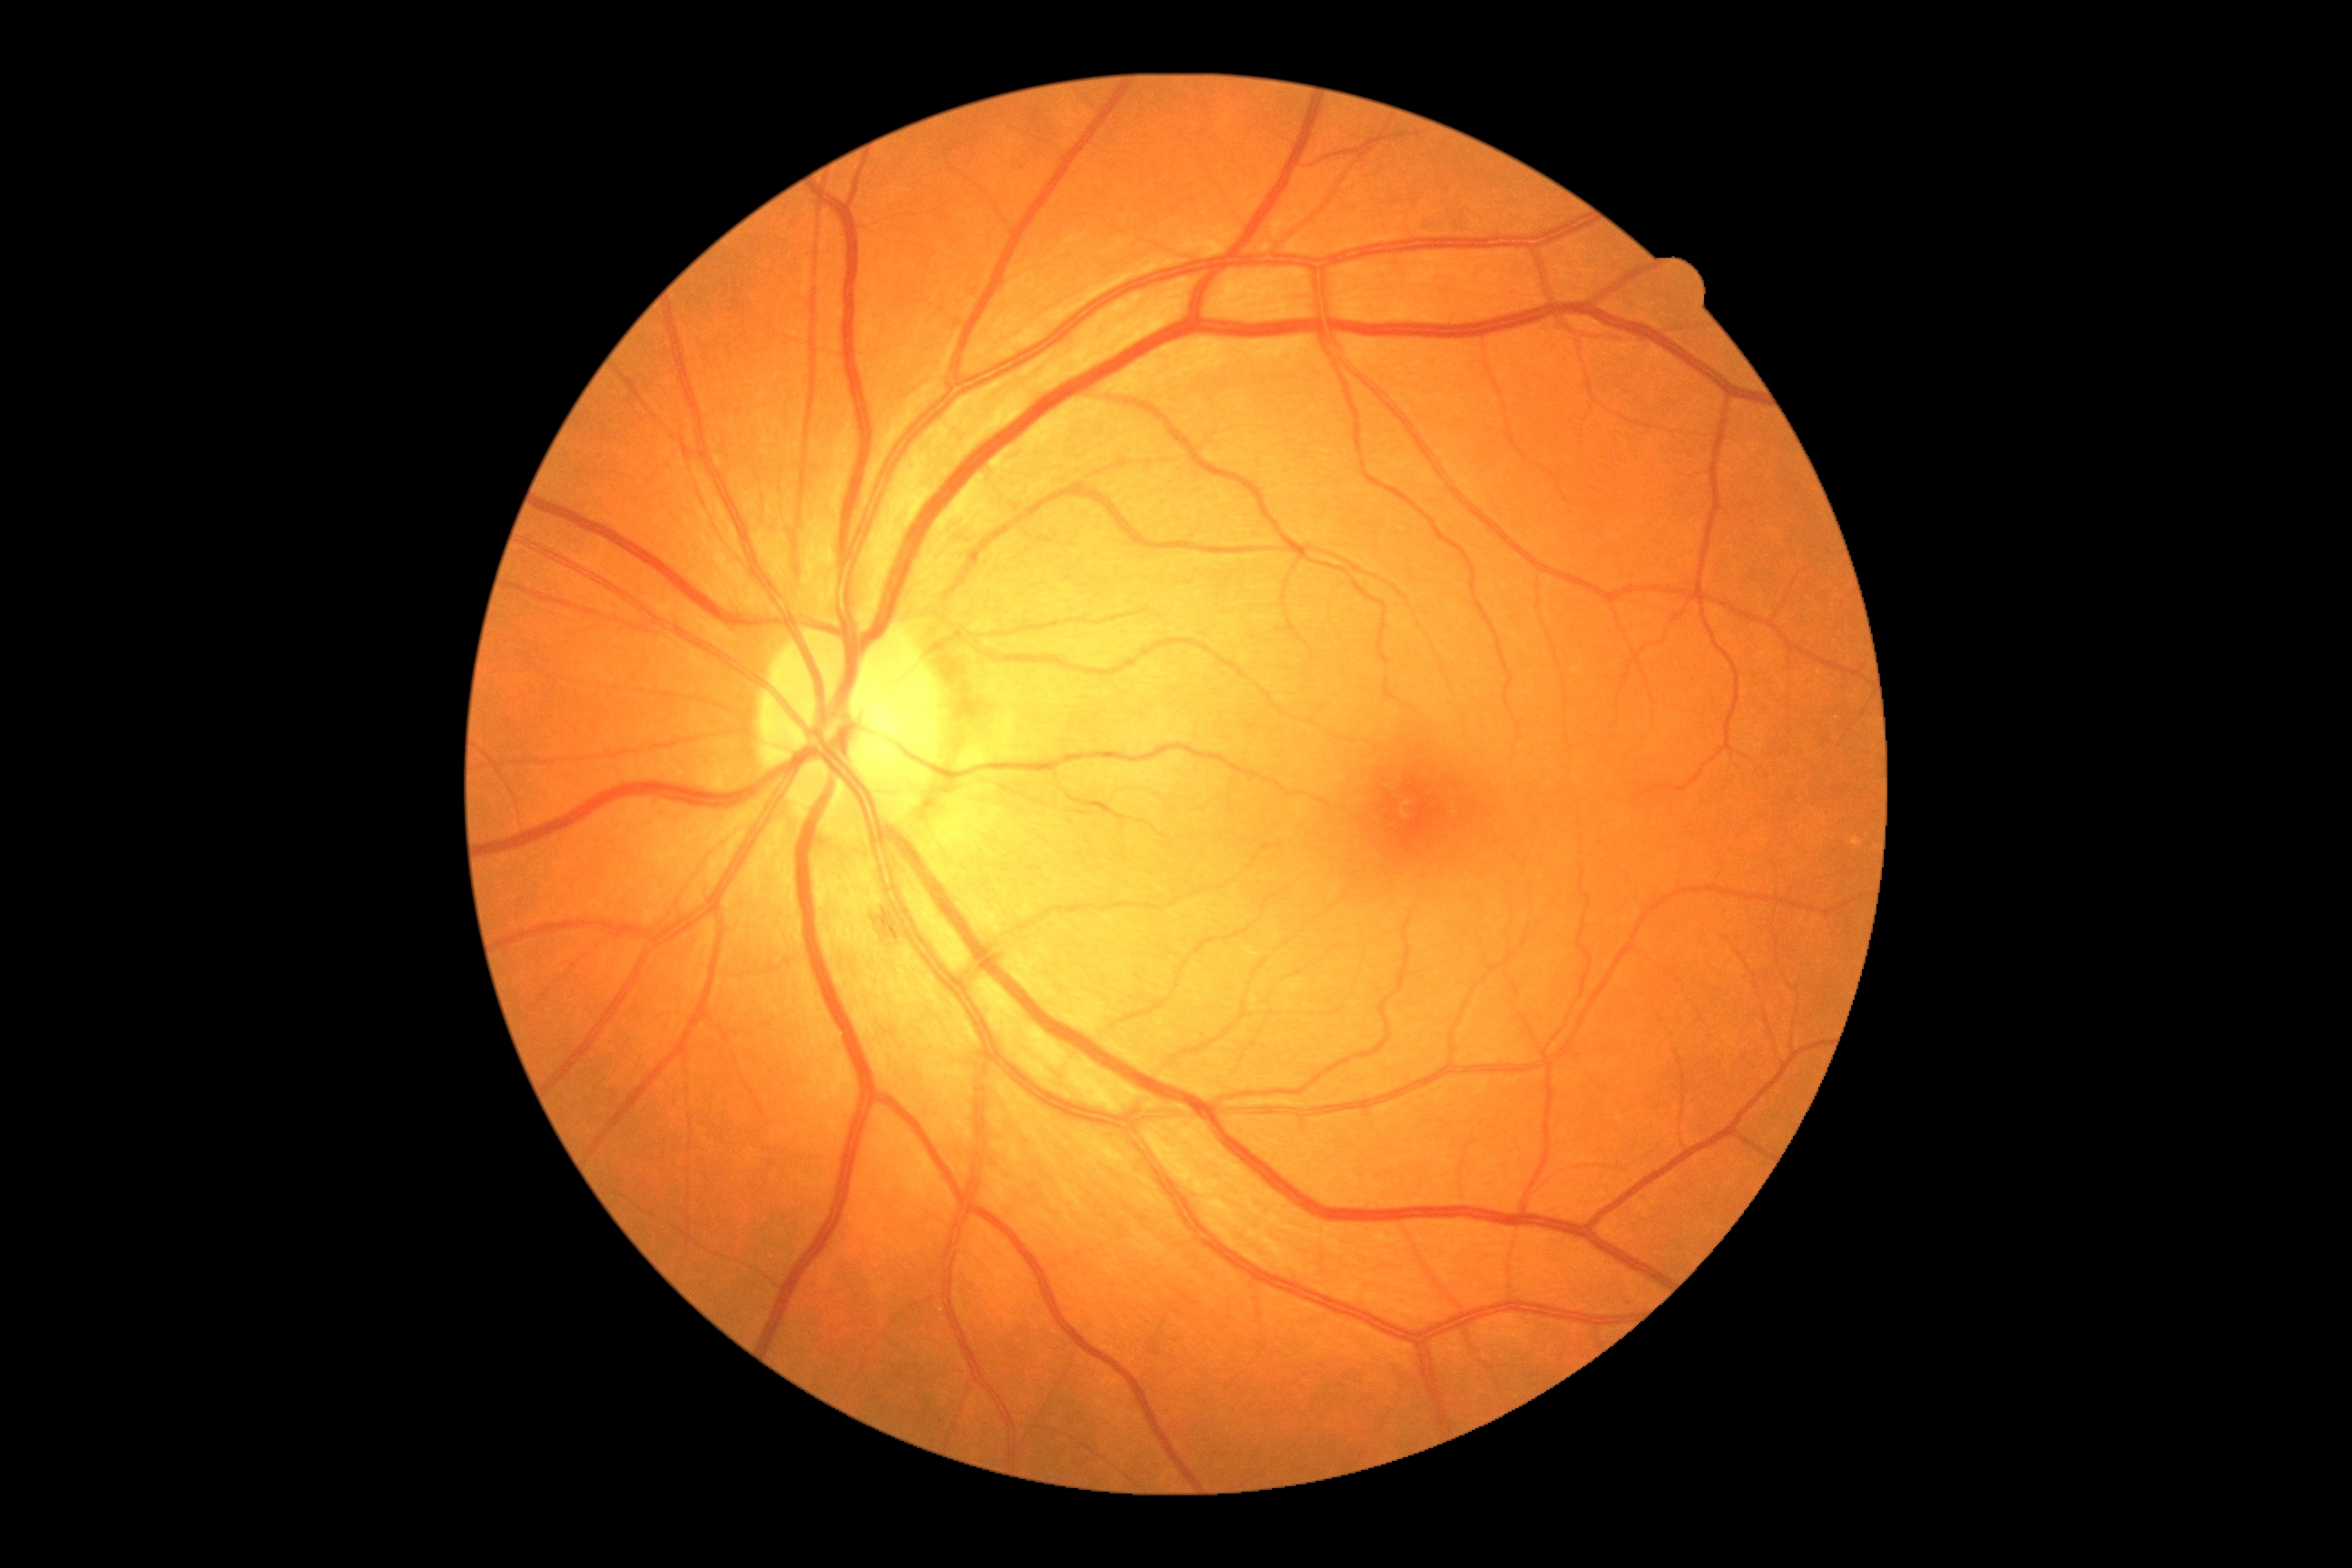 DR severity is grade 2 (moderate NPDR) — more than just microaneurysms but less than severe NPDR.
The retinopathy is classified as non-proliferative diabetic retinopathy.